Wide-field fundus image from infant ROP screening
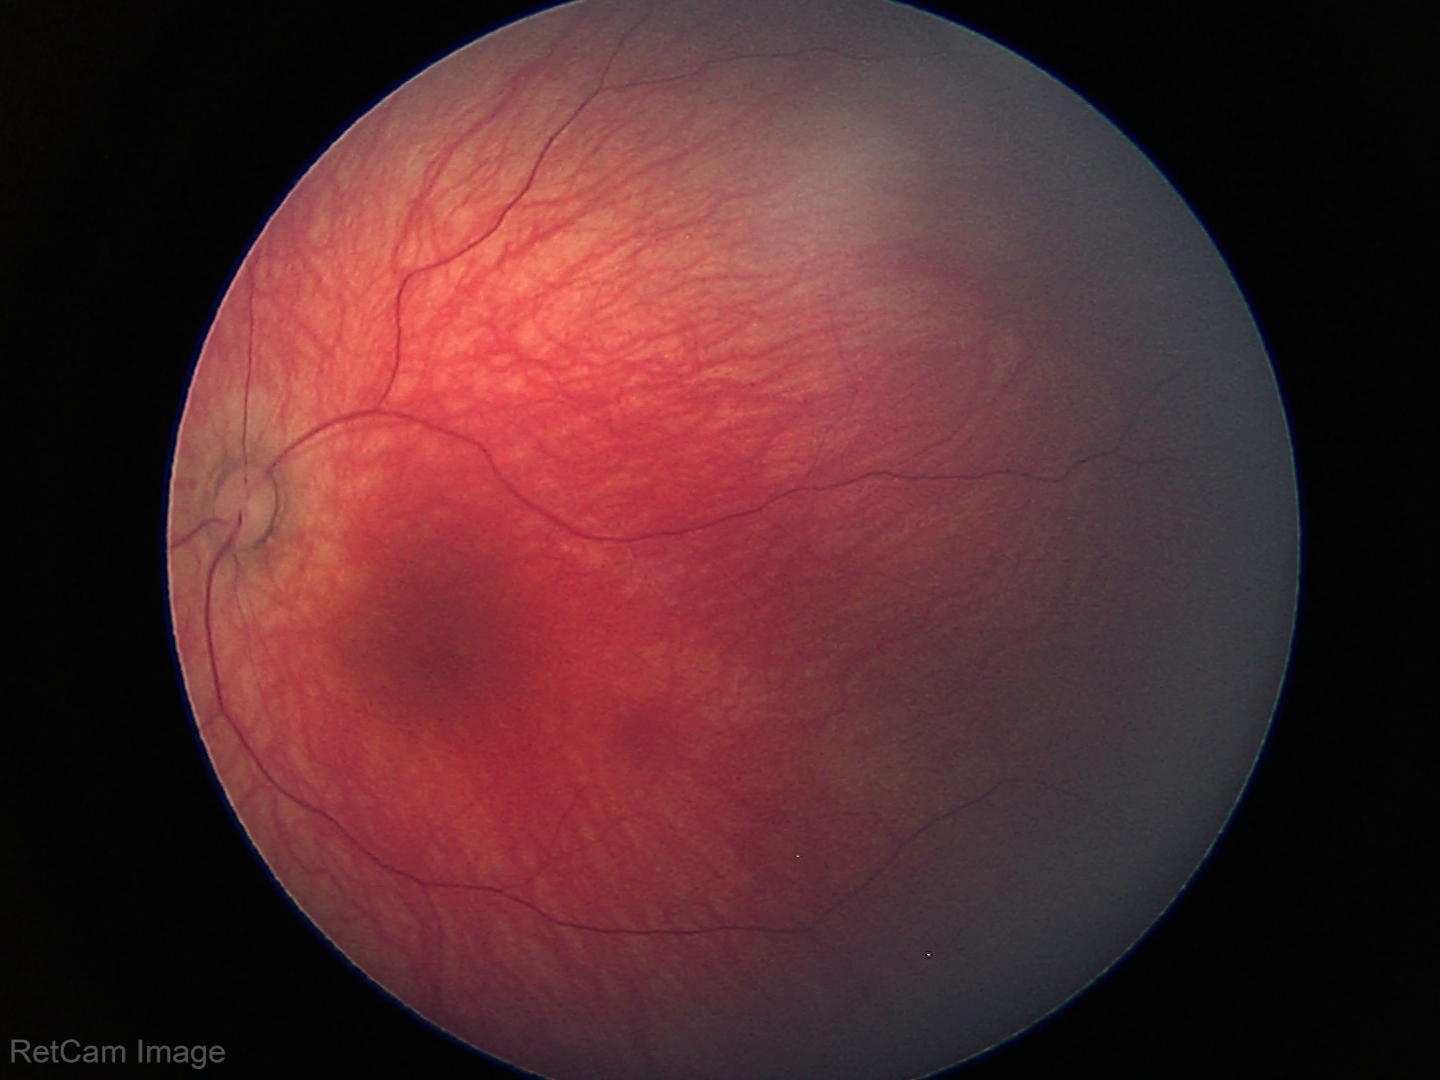
Screening examination diagnosed as physiological.